Pachymetry: 512 µm; intraocular pressure (IOP) 13 mmHg by pneumatic tonometry; sex: male.
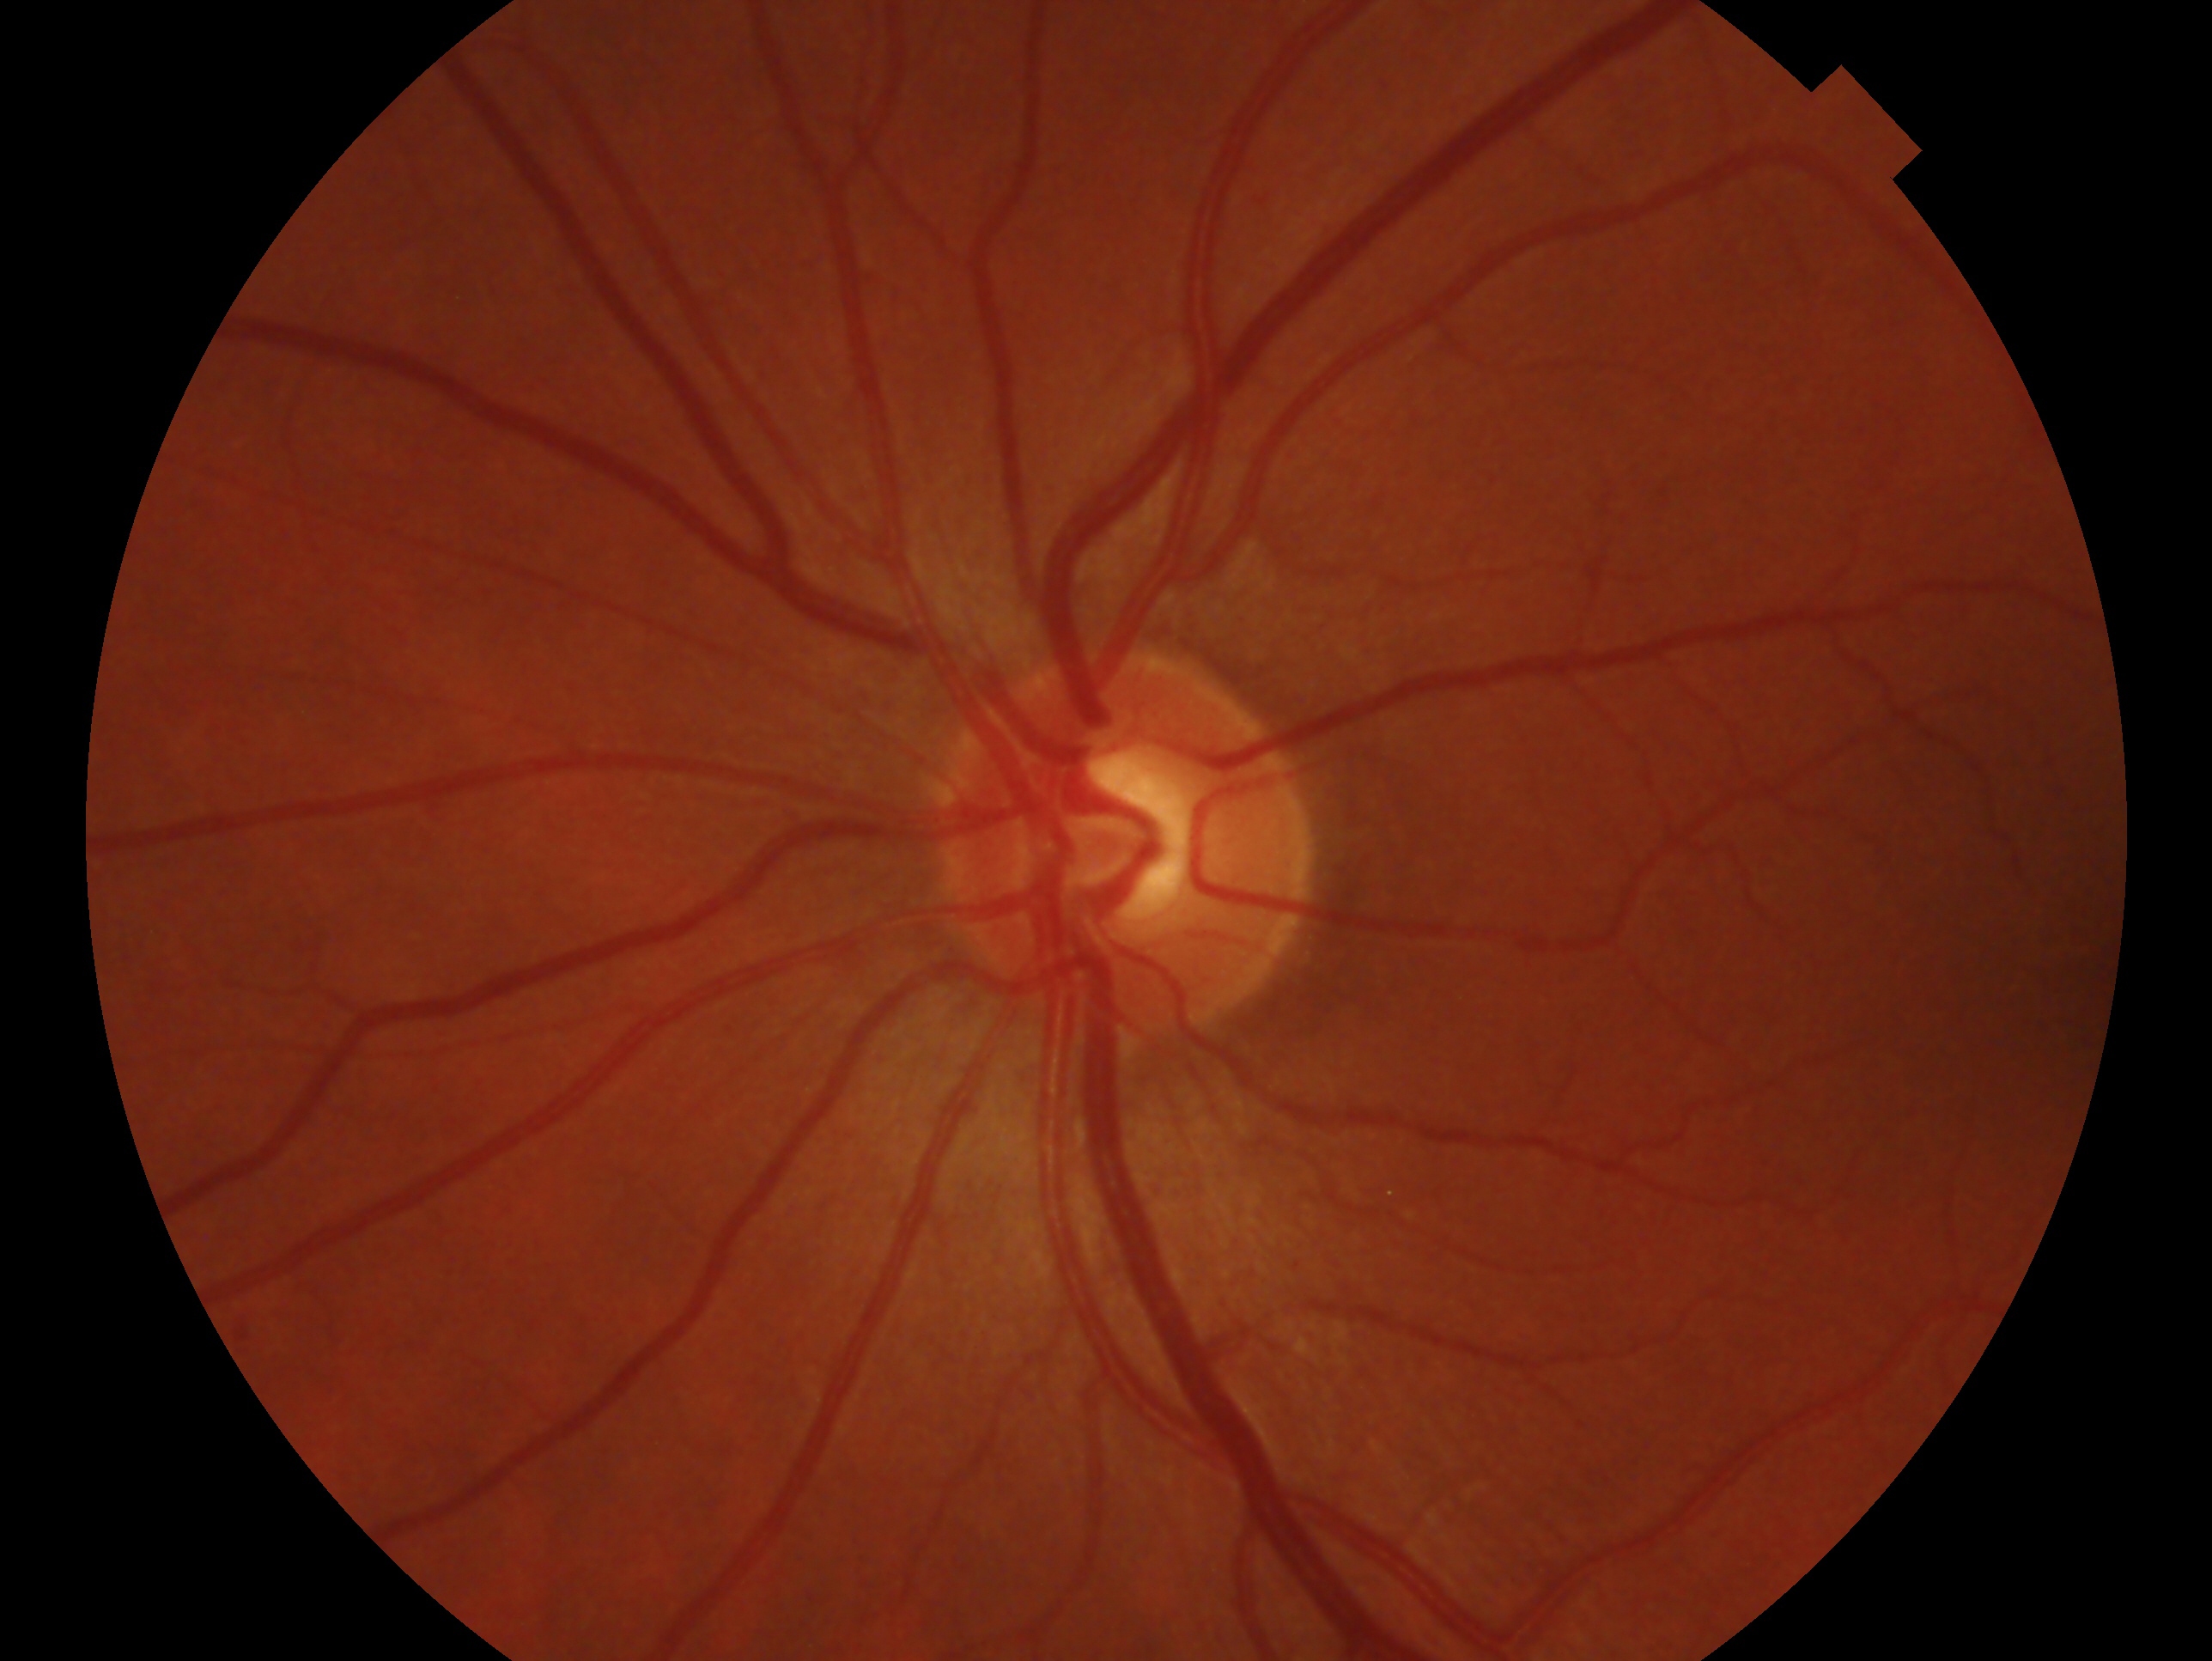 eye: OS; assessment: no glaucomatous findings.